1932x1910px; CFP; FOV: 45 degrees — 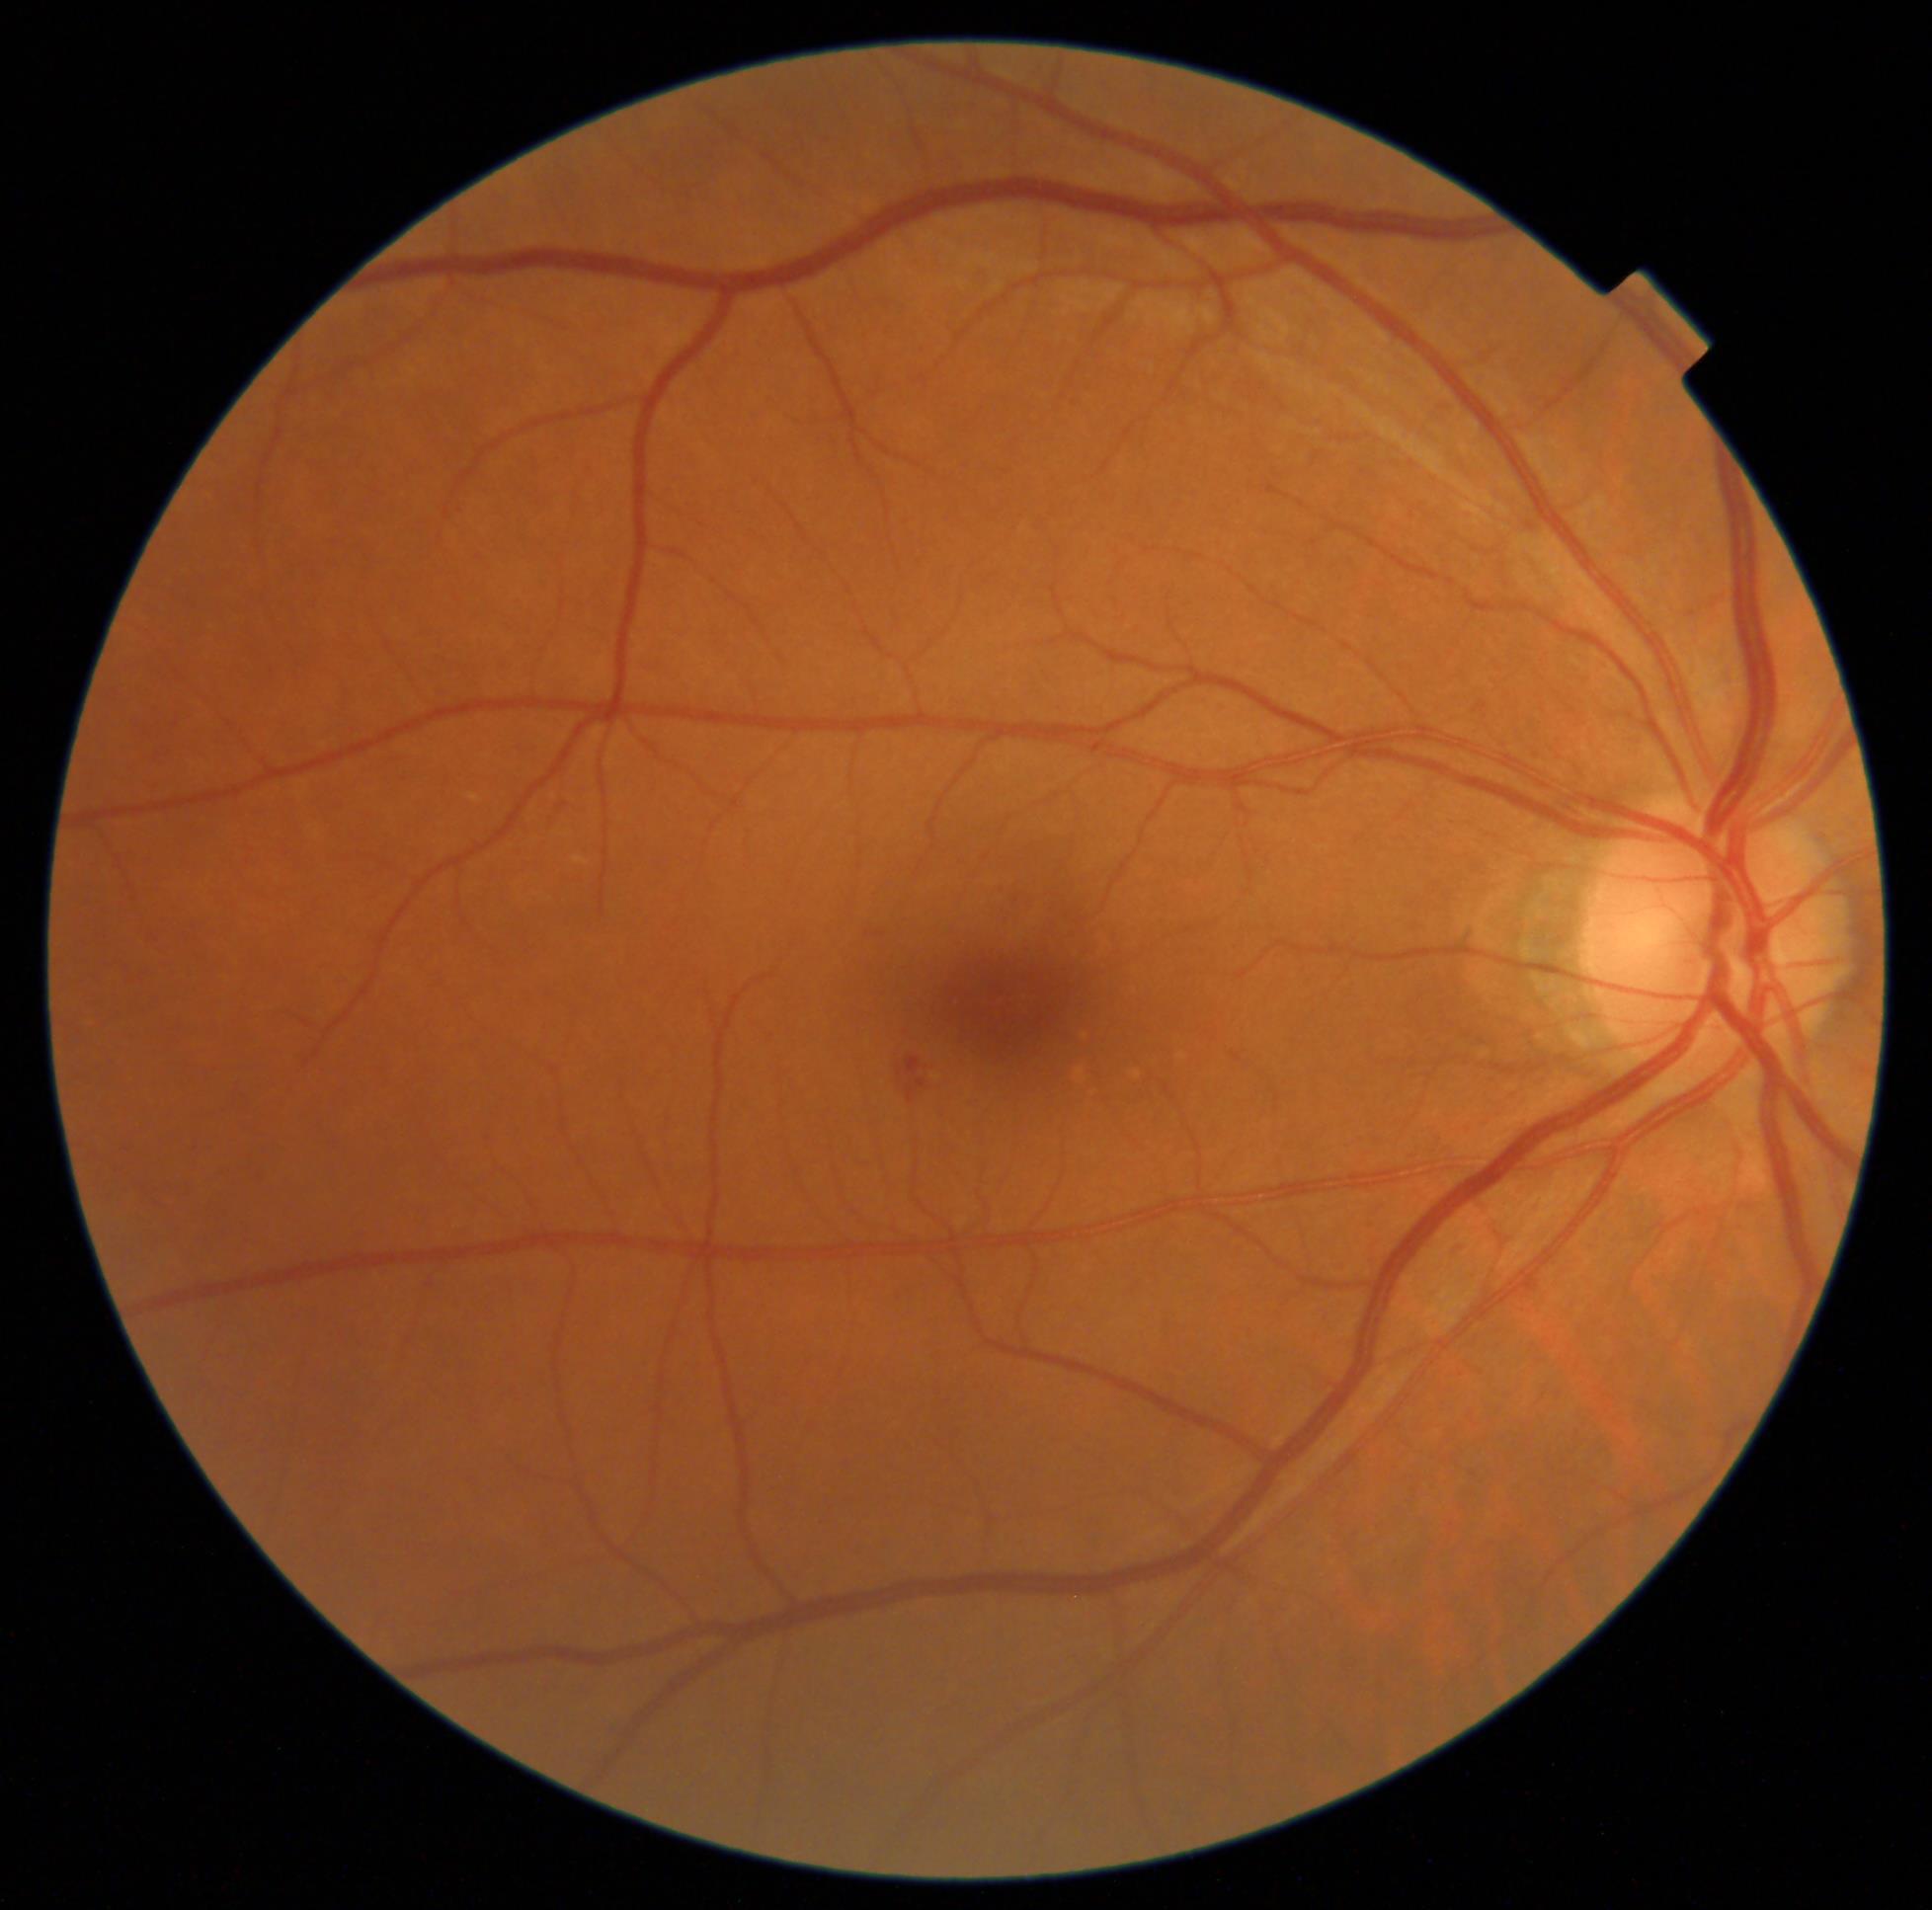
Diabetic retinopathy grade: 2.
The retinopathy is classified as non-proliferative diabetic retinopathy.